Ultra-widefield (UWF) fundus image.
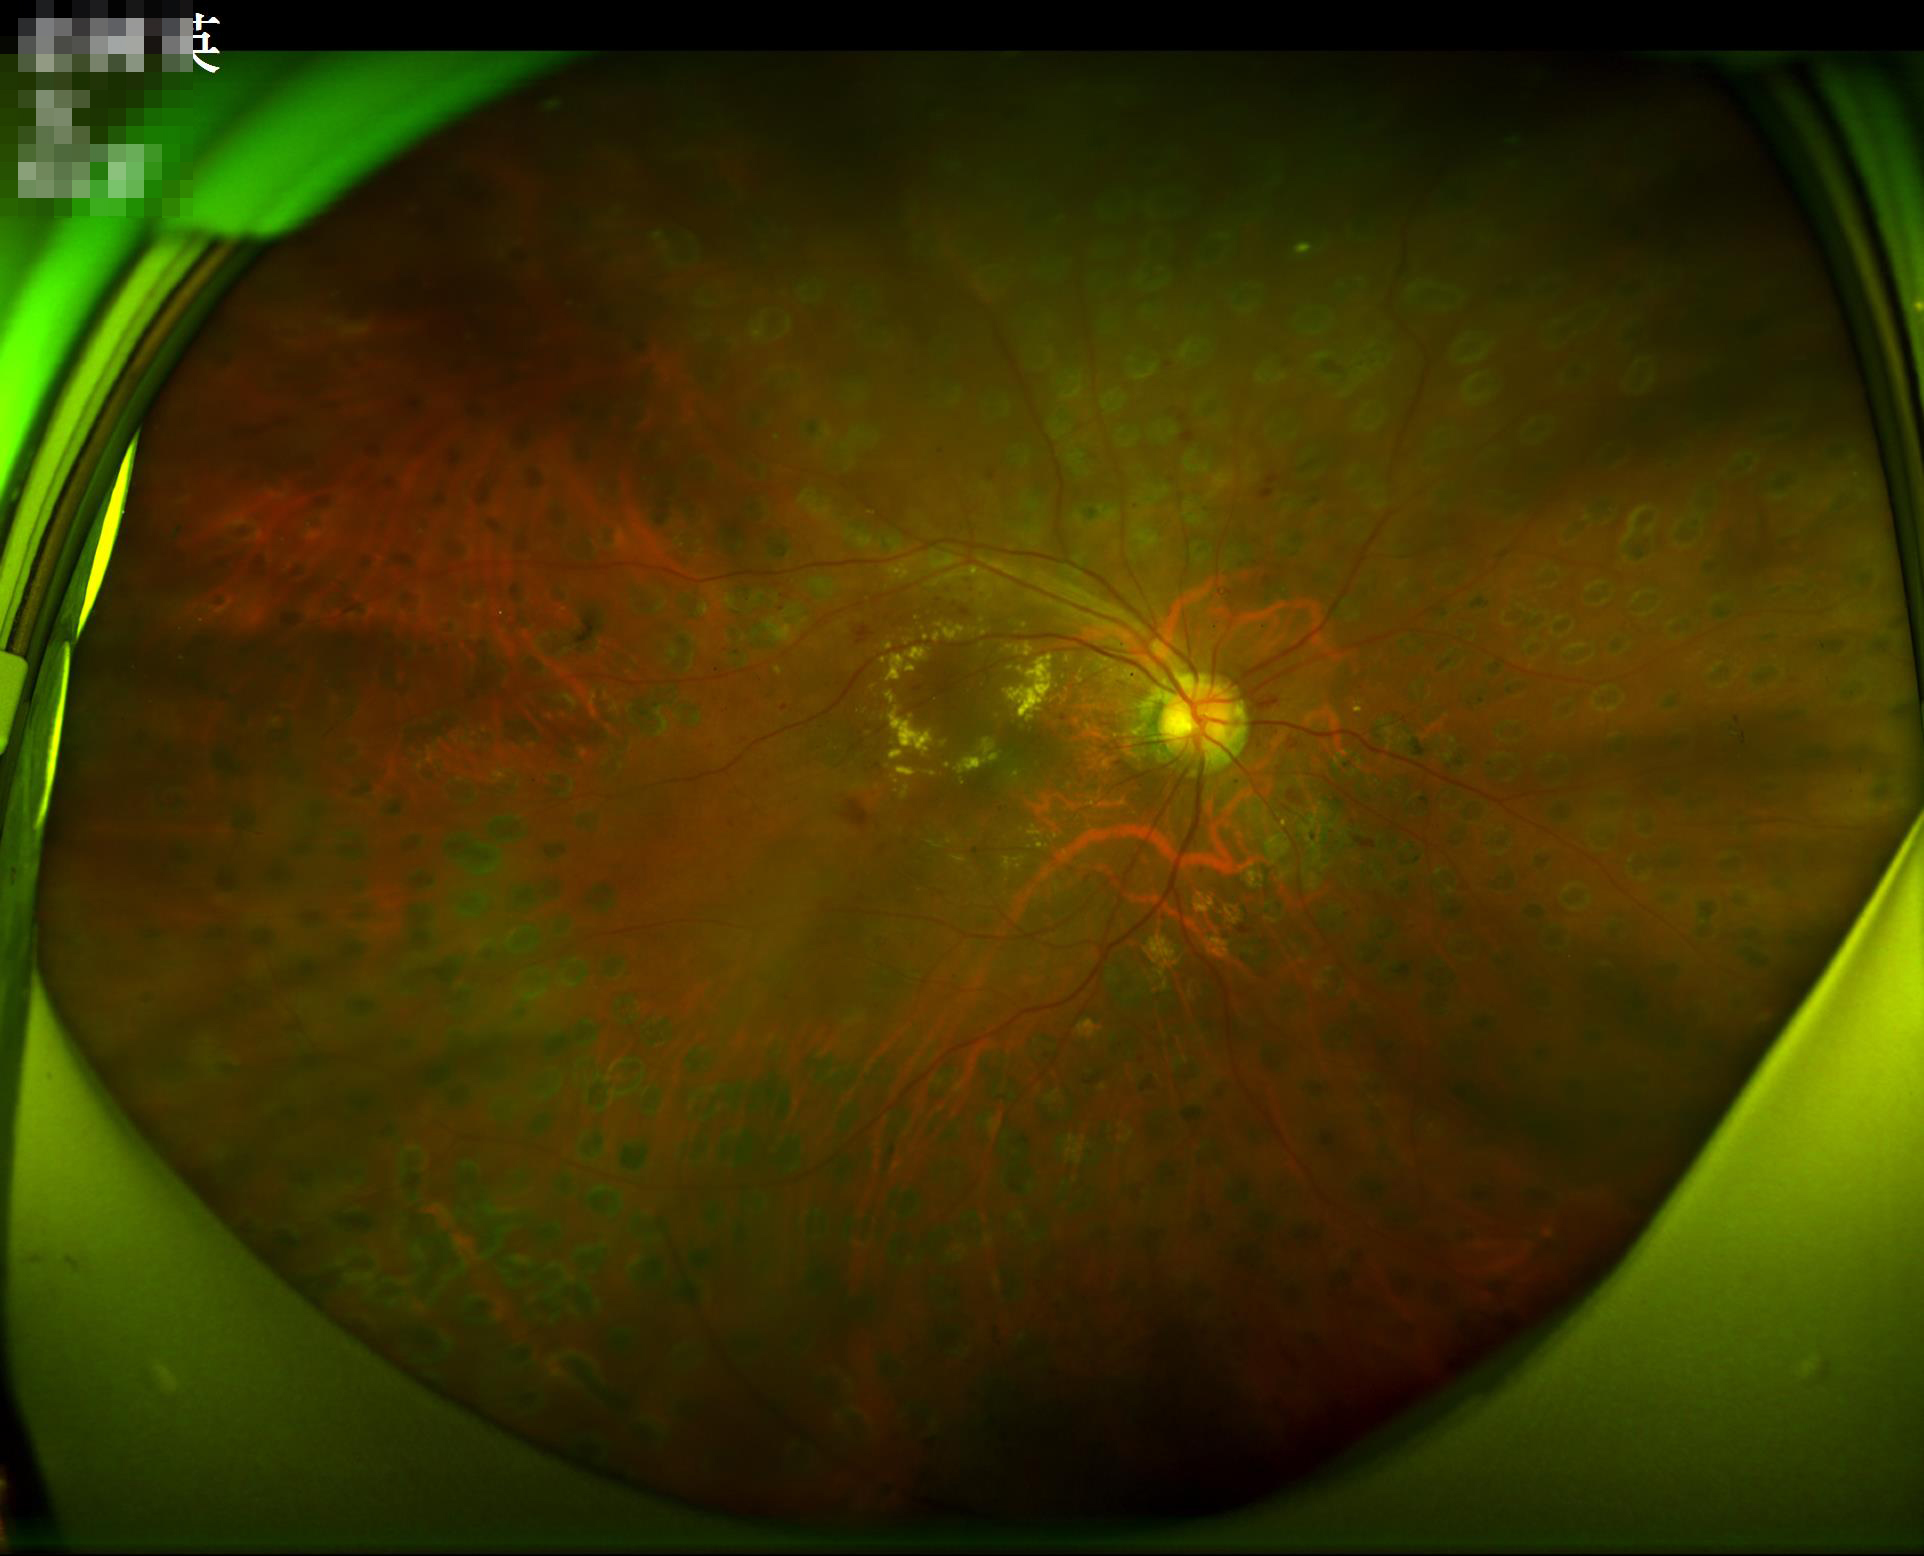
Illumination is uneven. Acceptable image quality. No noticeable blur. Contrast is good.